Fundus photo: 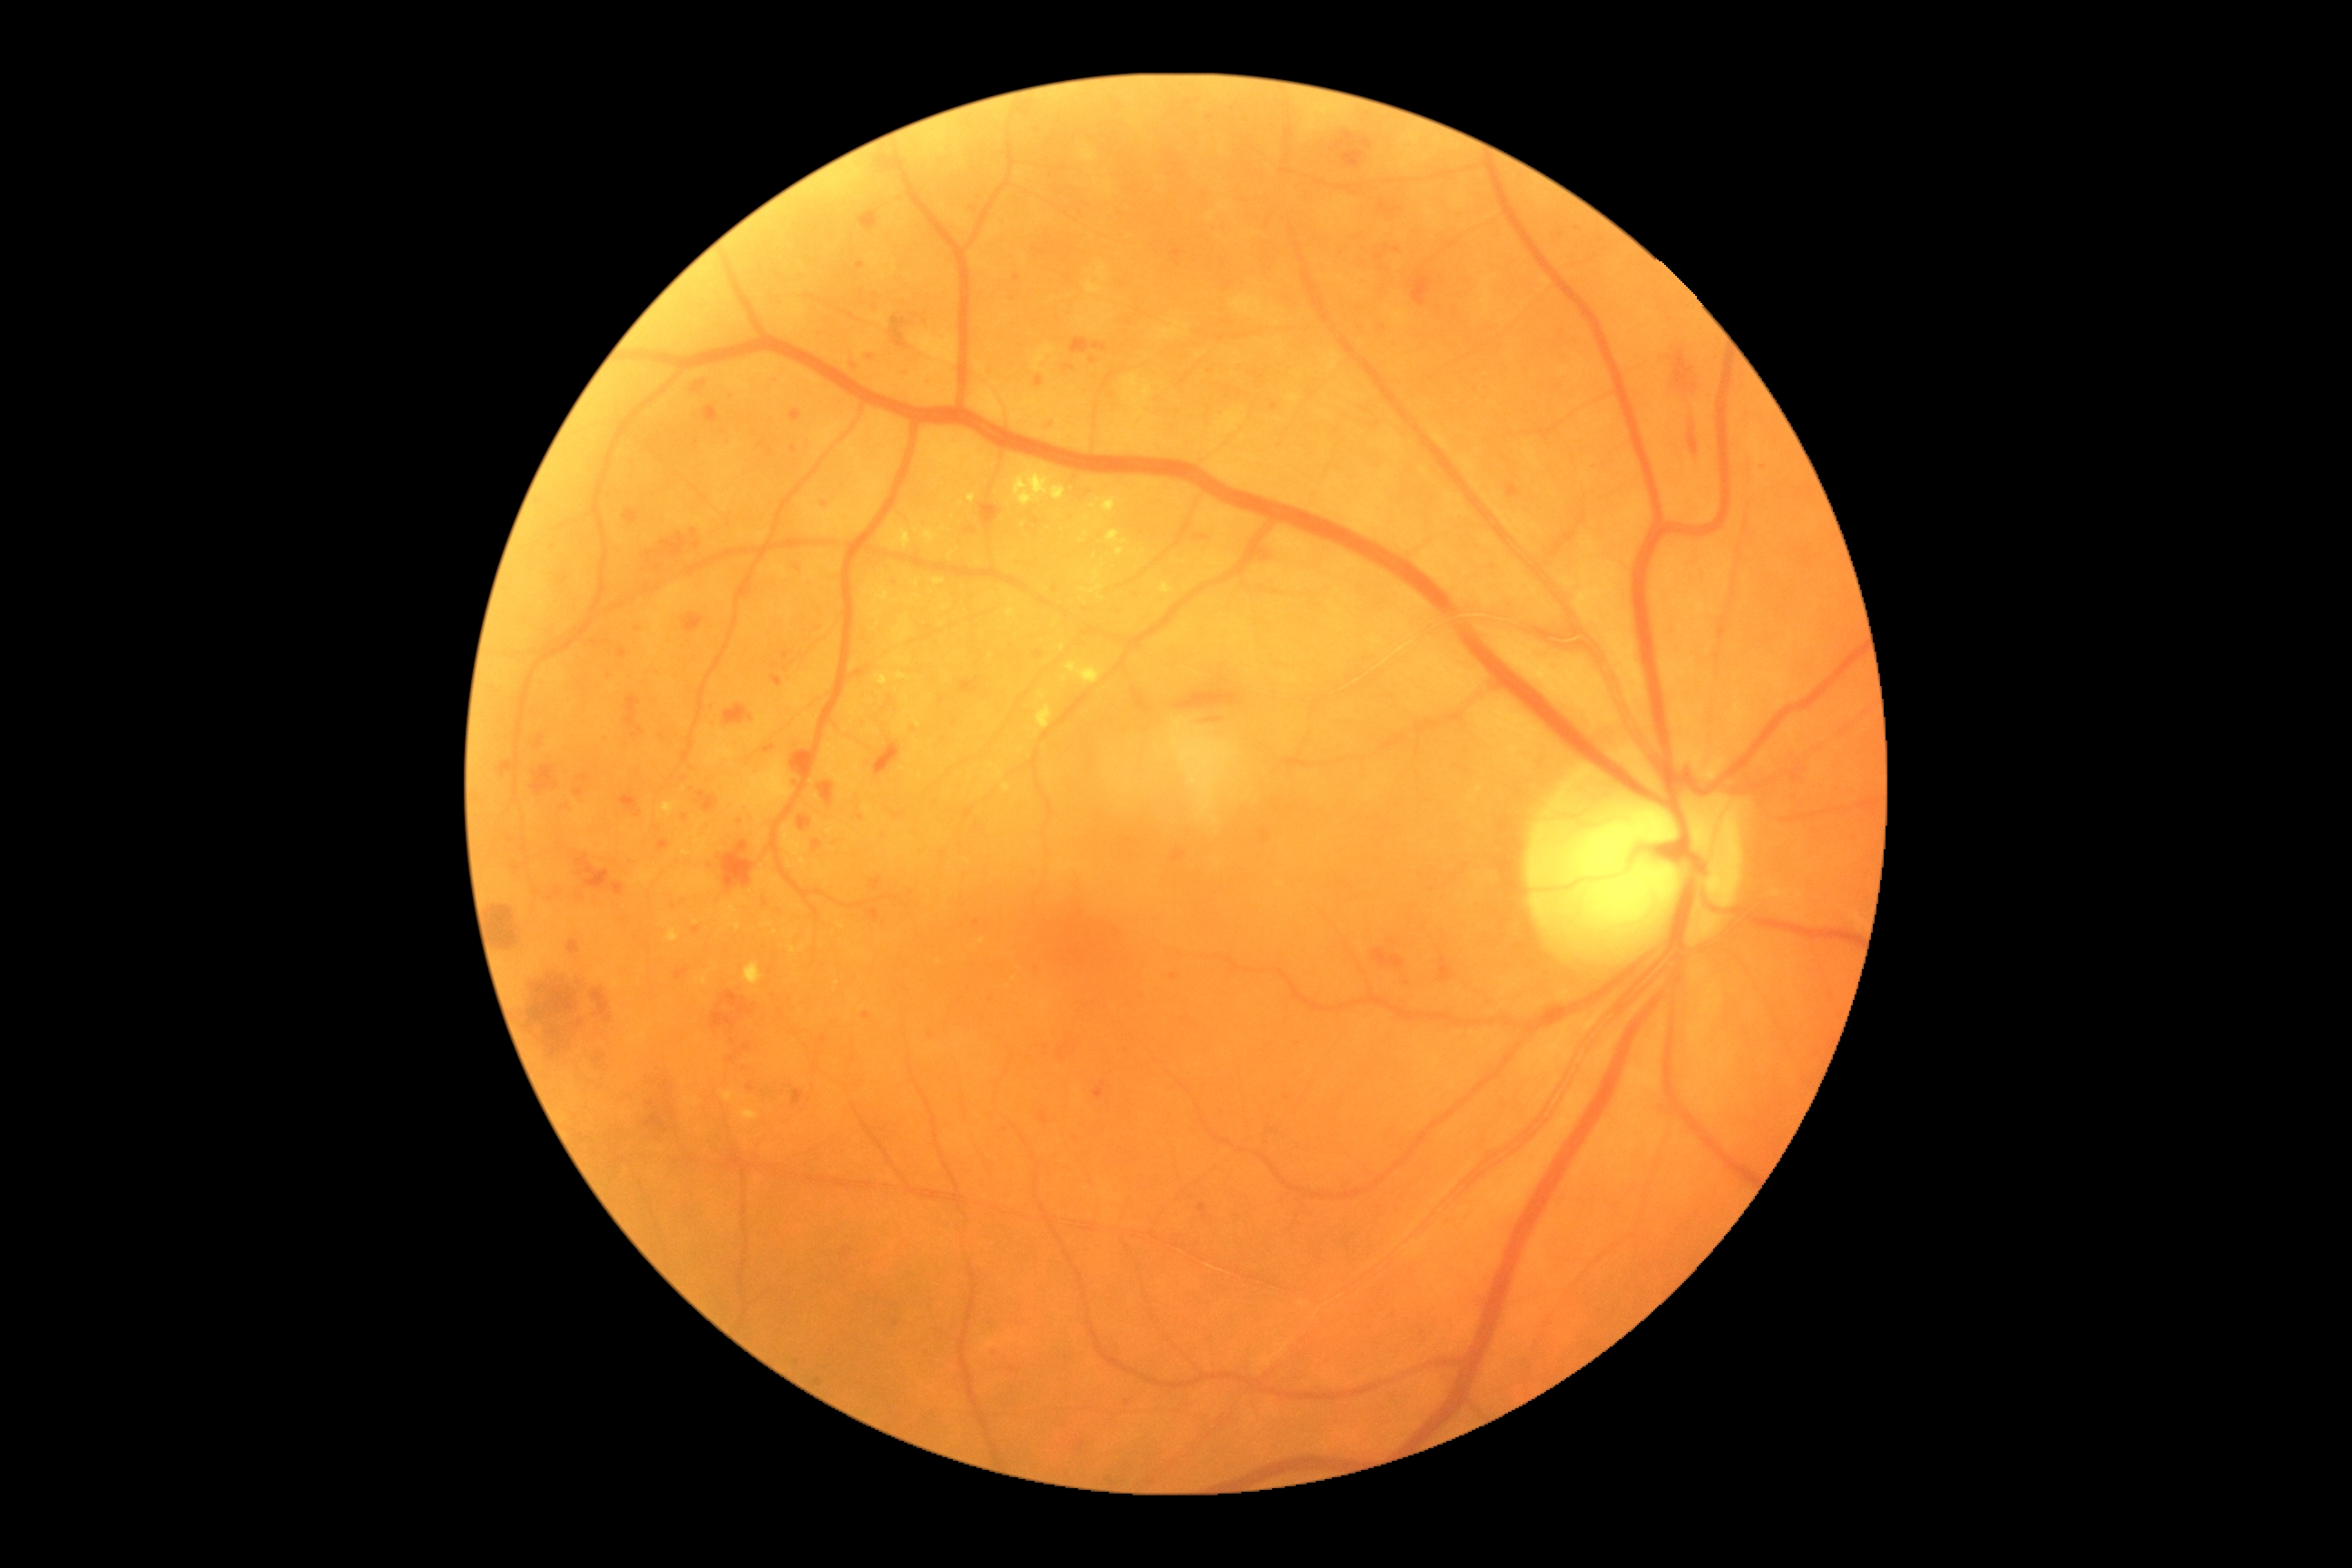

Annotations:
- diabetic retinopathy (DR): grade 3